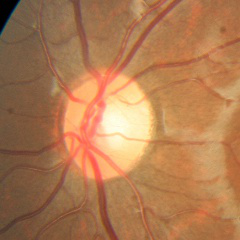
Glaucoma status: no glaucoma.